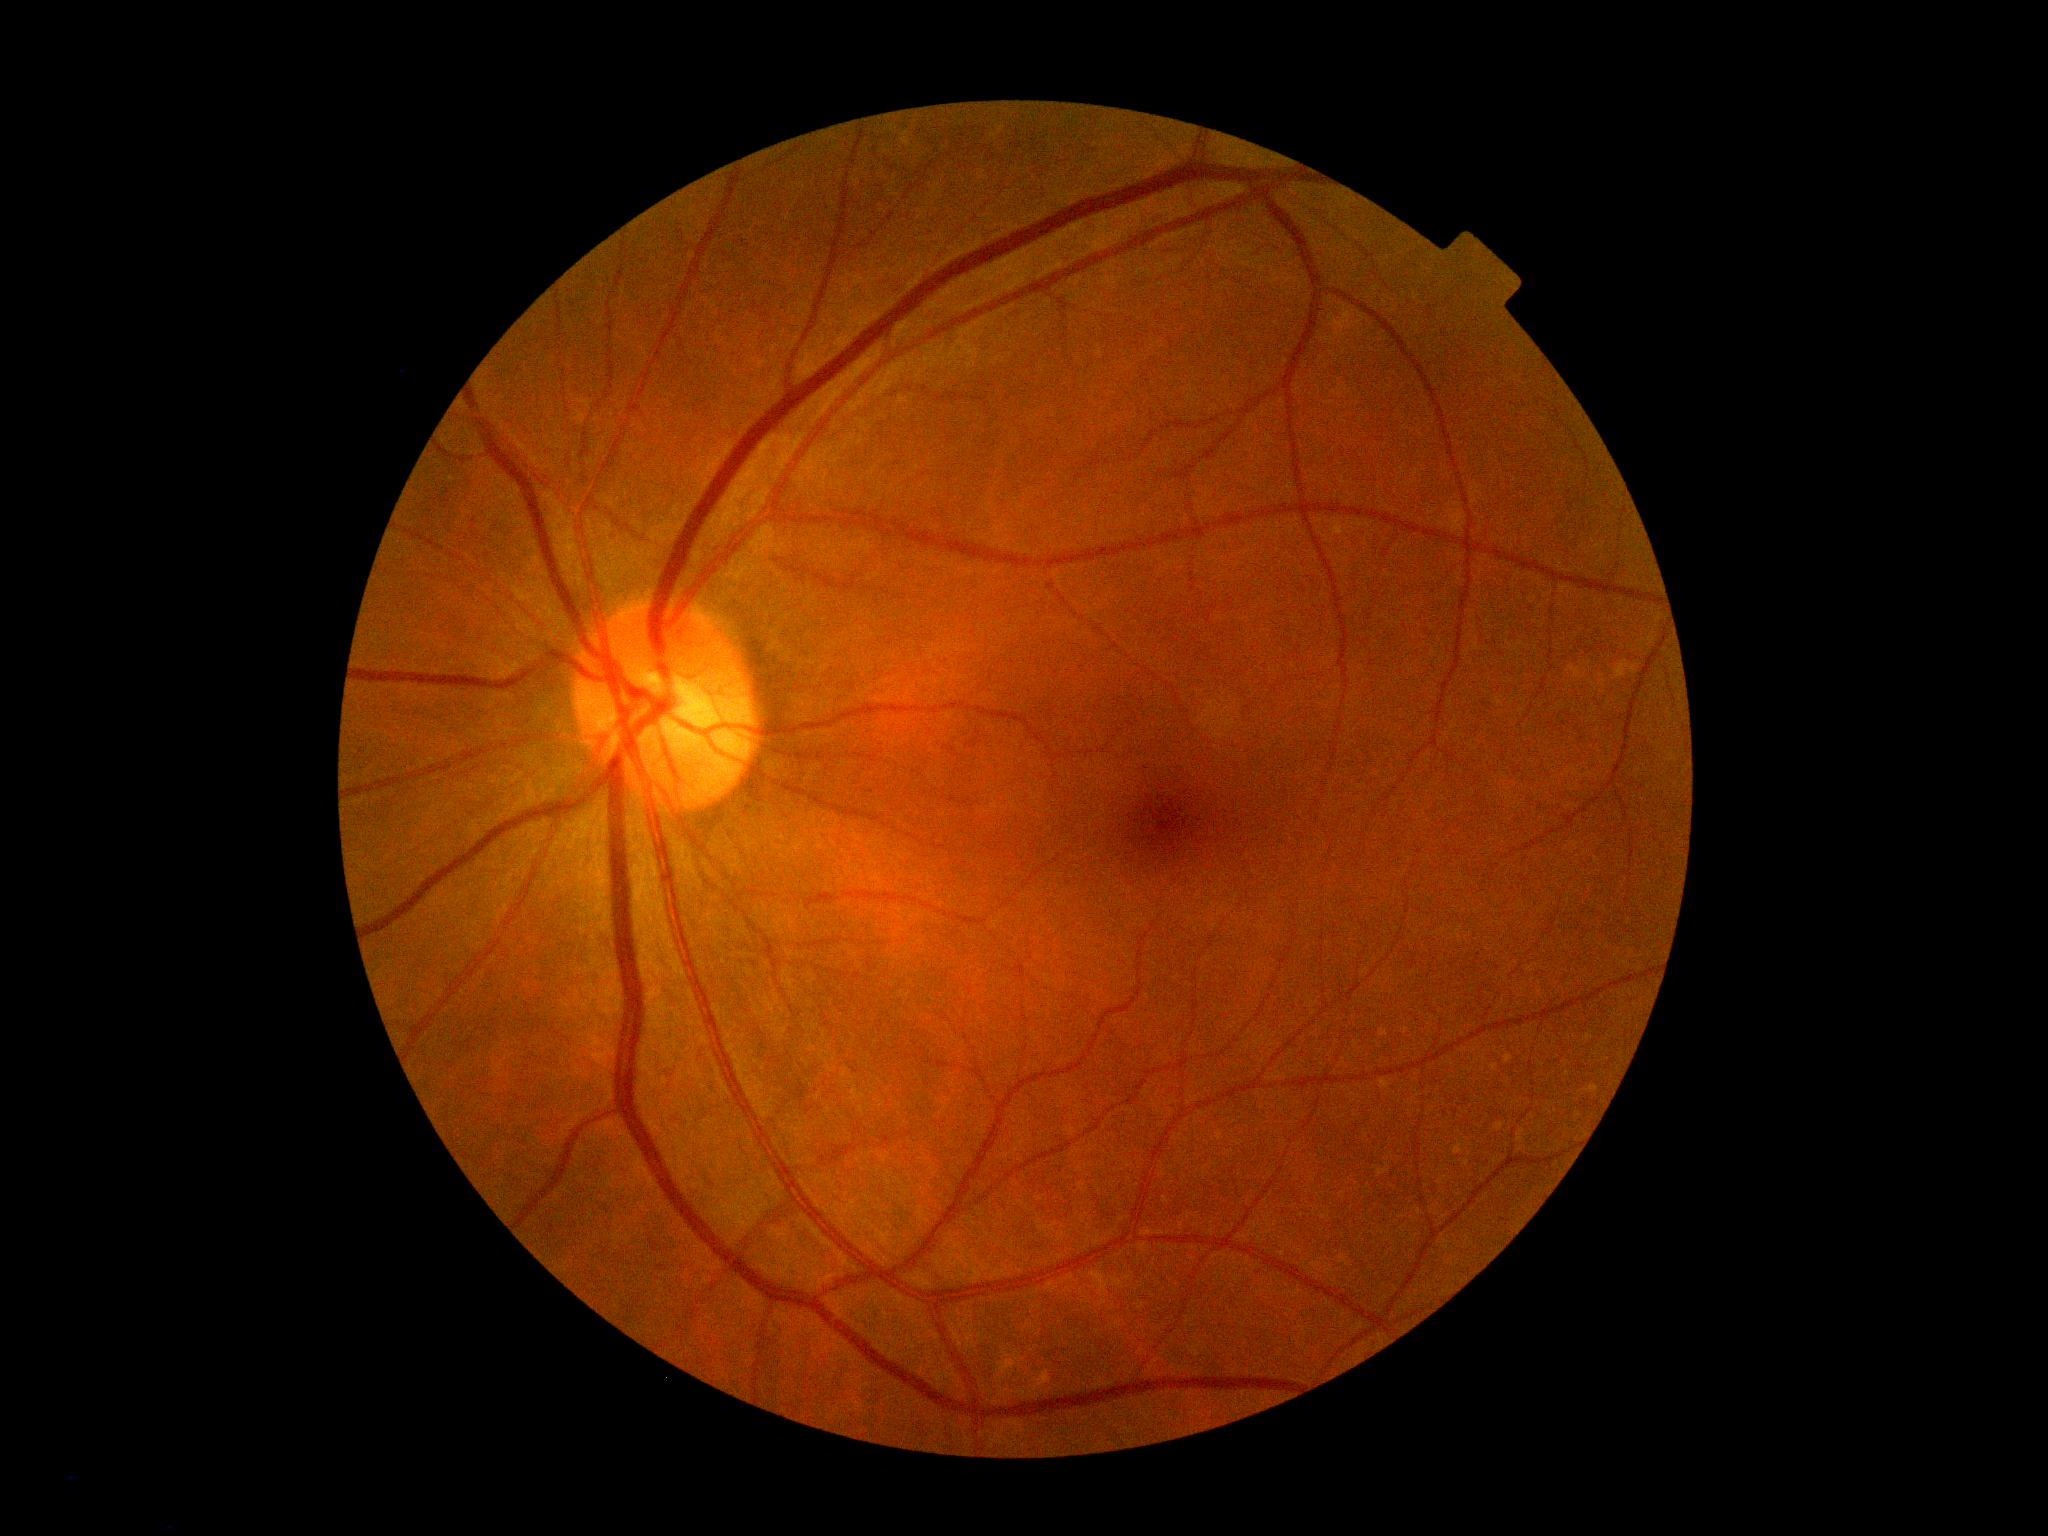
Diabetic retinopathy grade: 0. No DR findings.